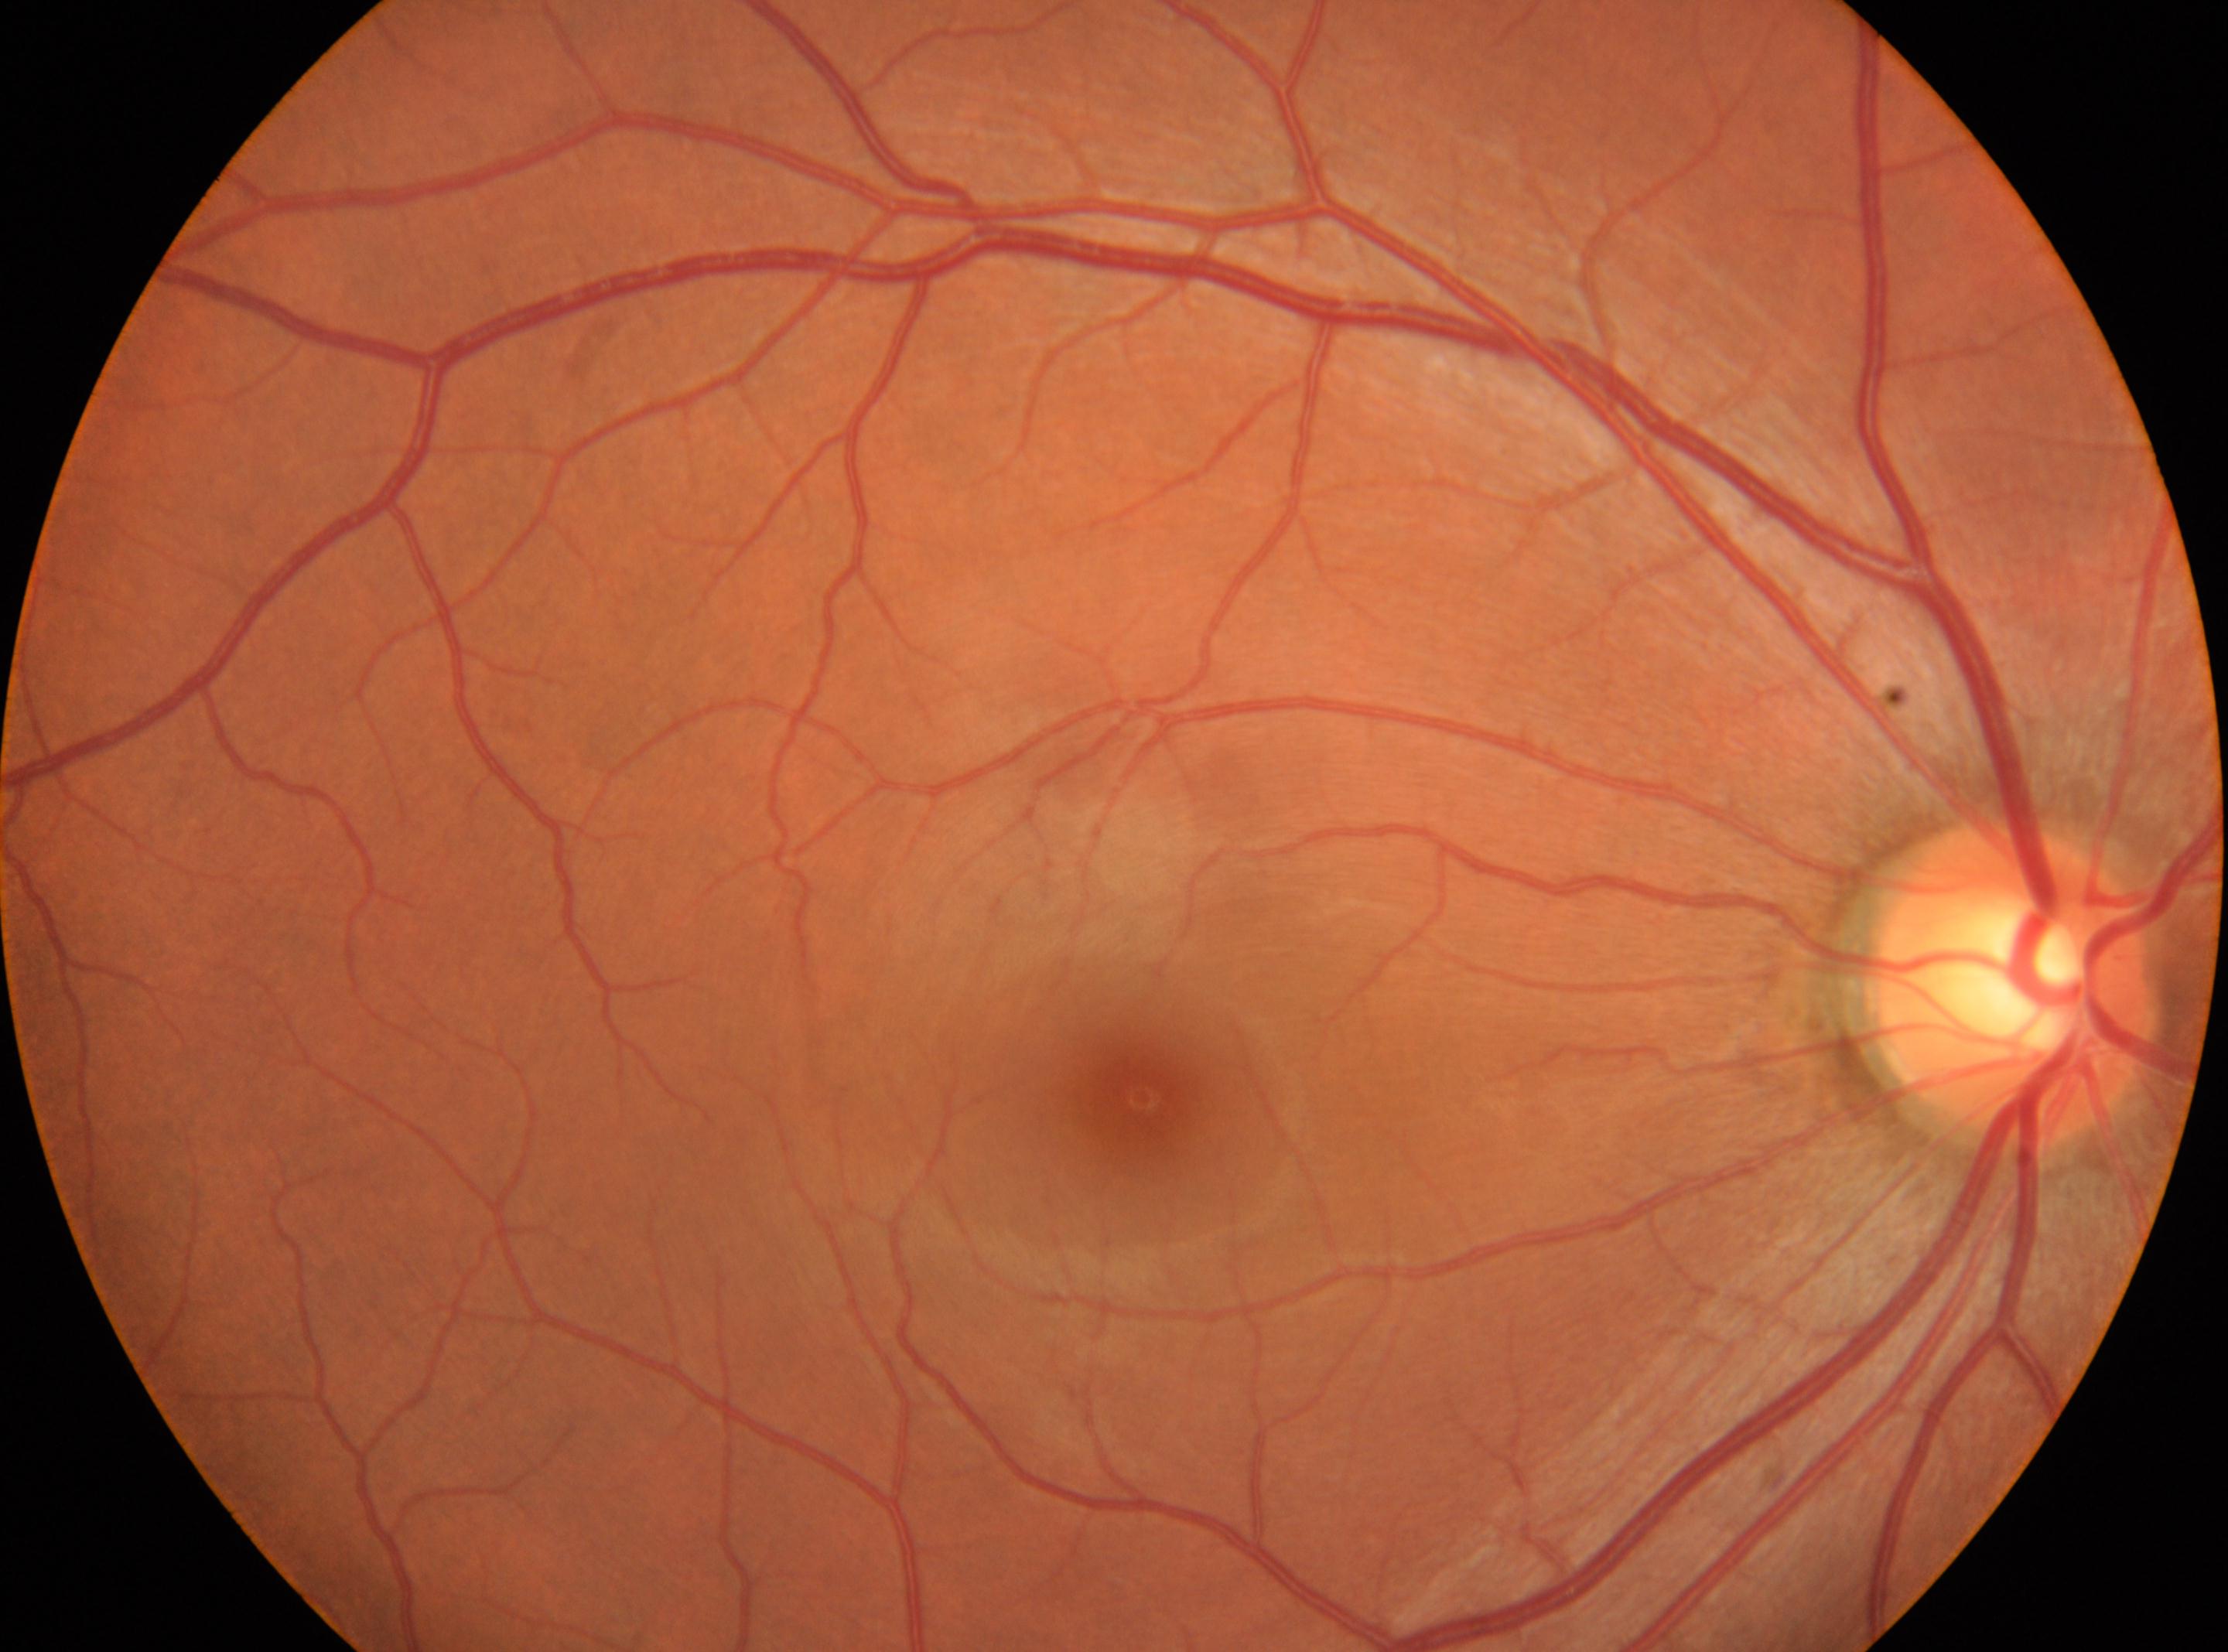 Imaged eye: the right eye. The macular center is at 1140px, 1095px. Diabetic retinopathy severity: no apparent retinopathy (grade 0). The optic nerve head is at 2007px, 980px.